848 x 848 pixels · nonmydriatic.
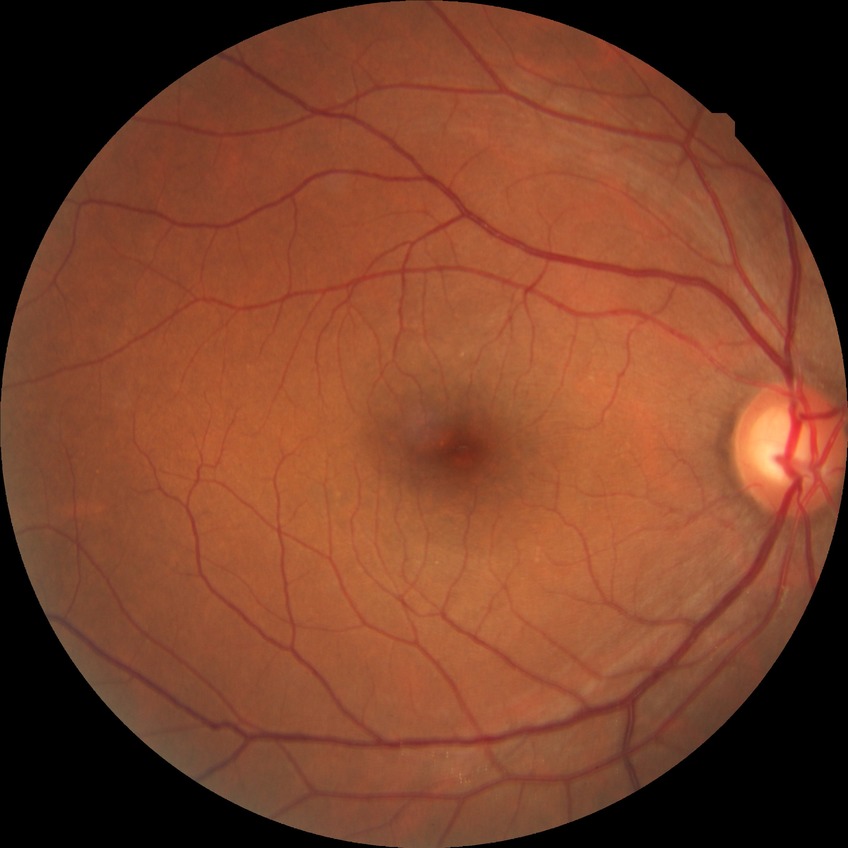 DR impression=no apparent DR; DR stage=NDR.